2048 by 1536 pixels — 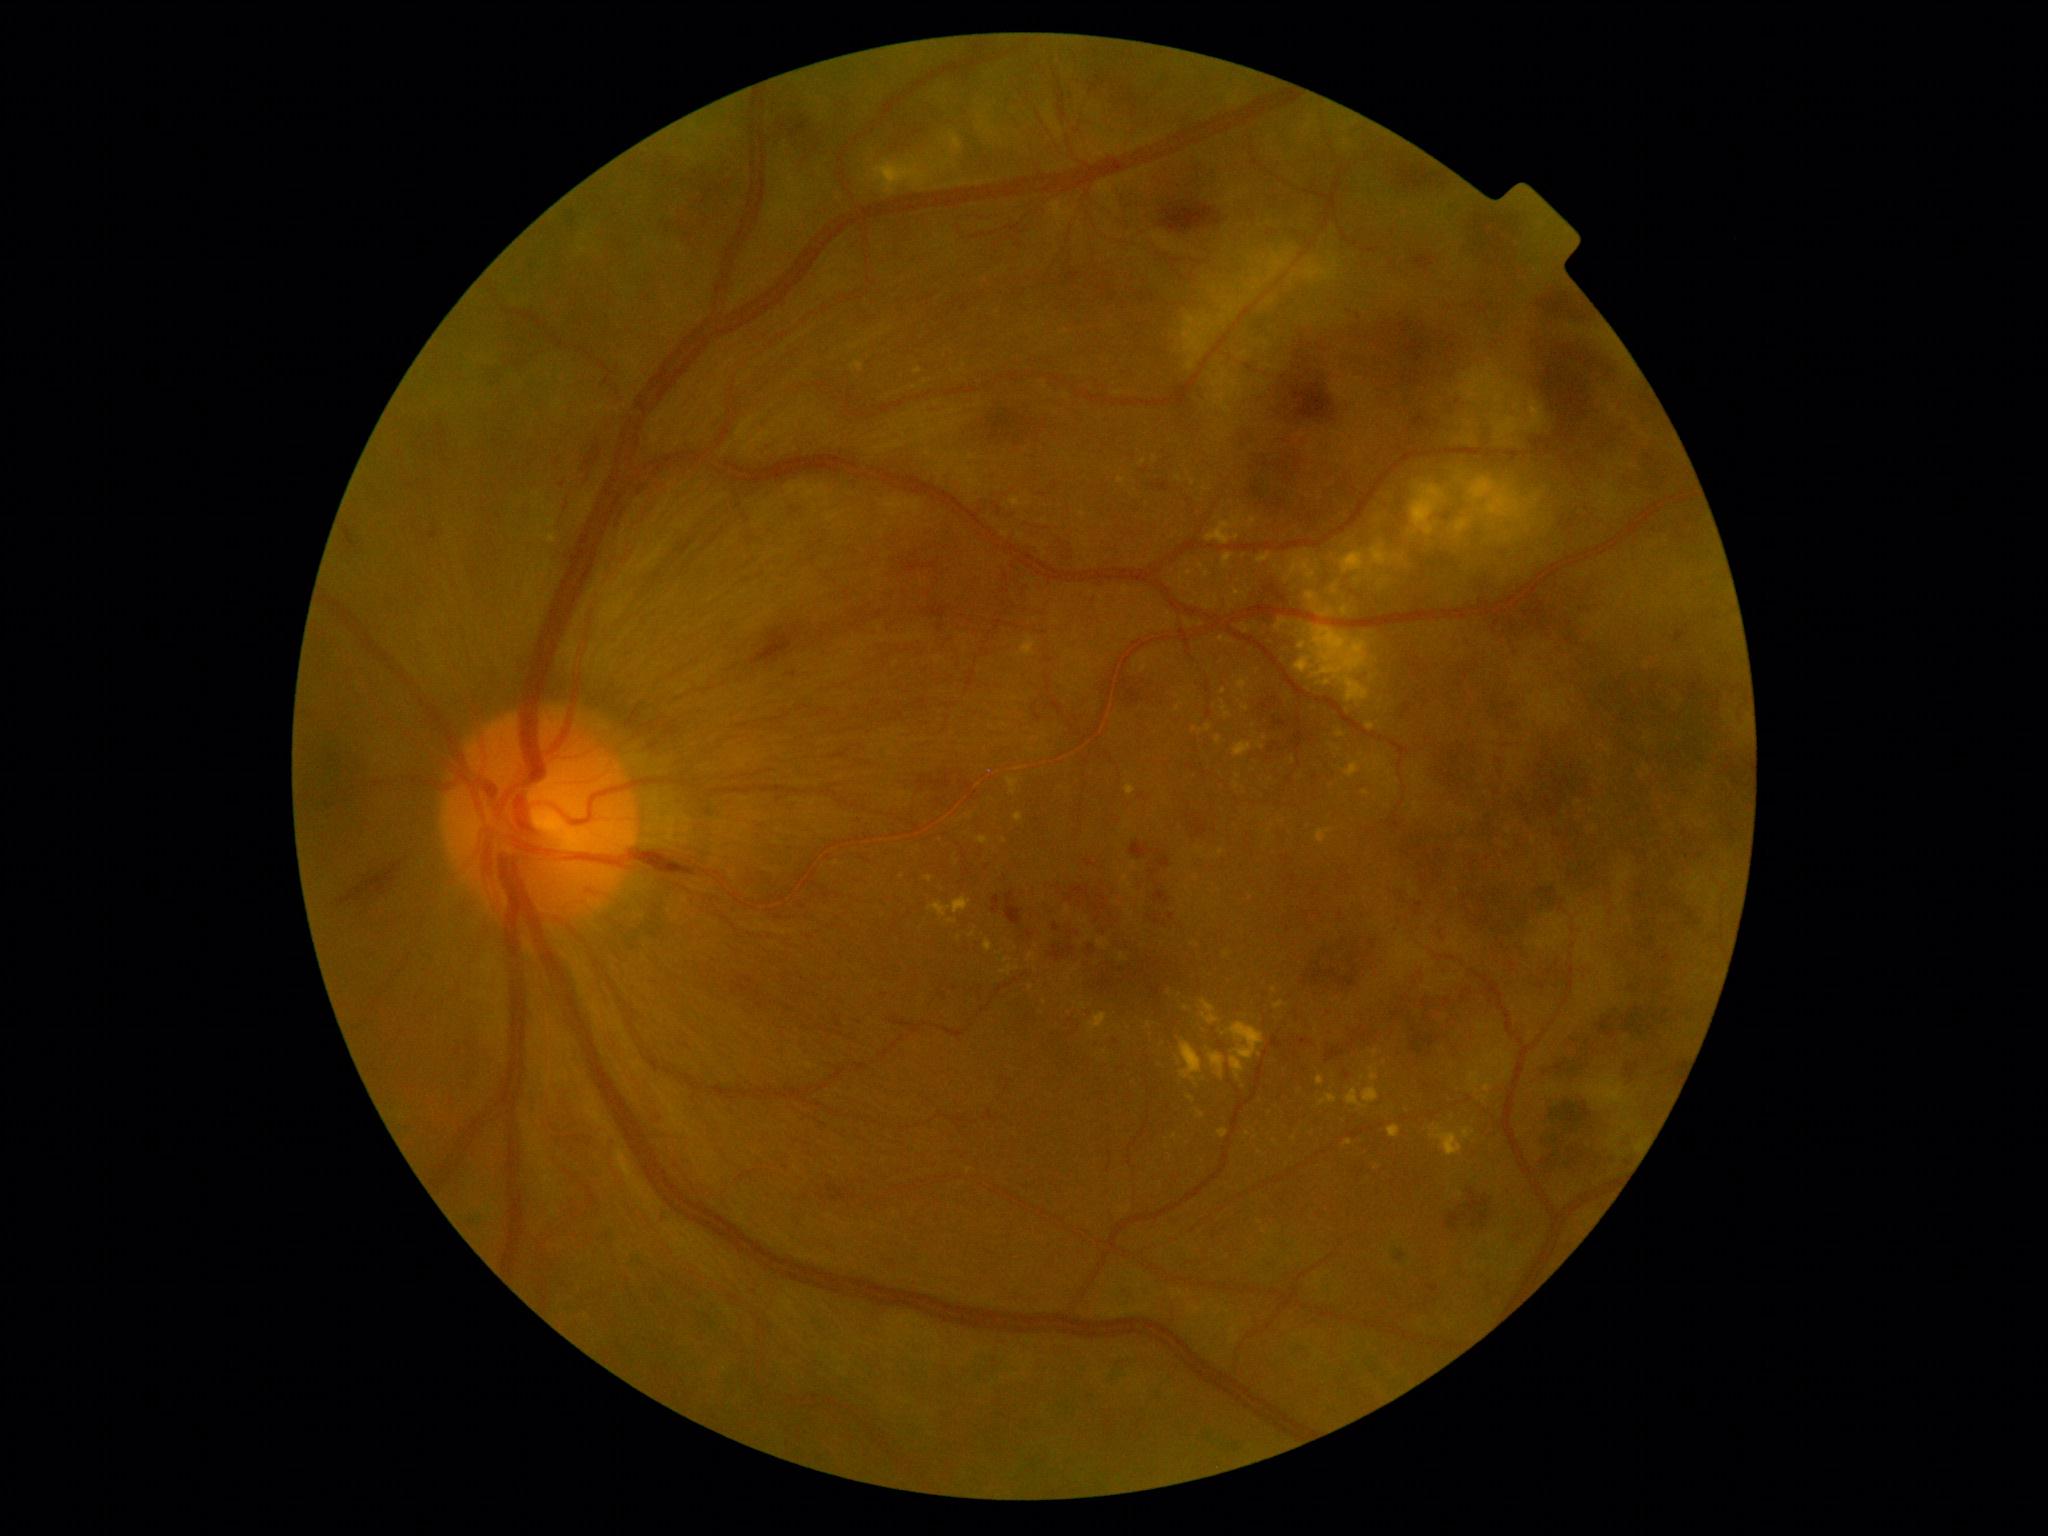

Diabetic retinopathy grade: 4/4
A subset of detected lesions:
hard exudates (continued): {"left": 852, "top": 362, "right": 865, "bottom": 372} | {"left": 1320, "top": 1094, "right": 1337, "bottom": 1107} | {"left": 1388, "top": 1125, "right": 1400, "bottom": 1138} | {"left": 1120, "top": 952, "right": 1128, "bottom": 961} | {"left": 1204, "top": 601, "right": 1216, "bottom": 610} | {"left": 1345, "top": 1140, "right": 1353, "bottom": 1146} | {"left": 1208, "top": 1052, "right": 1226, "bottom": 1080} | {"left": 1206, "top": 516, "right": 1241, "bottom": 546} | {"left": 948, "top": 919, "right": 958, "bottom": 925}
Small hard exudates approximately at <point>959, 937</point> | <point>1377, 1167</point> | <point>1149, 1025</point> | <point>1193, 484</point> | <point>1175, 1137</point> | <point>1201, 567</point> | <point>1376, 1053</point> | <point>1247, 696</point>